Camera: Natus RetCam Envision (130° FOV); 1440 by 1080 pixels; infant wide-field fundus photograph: 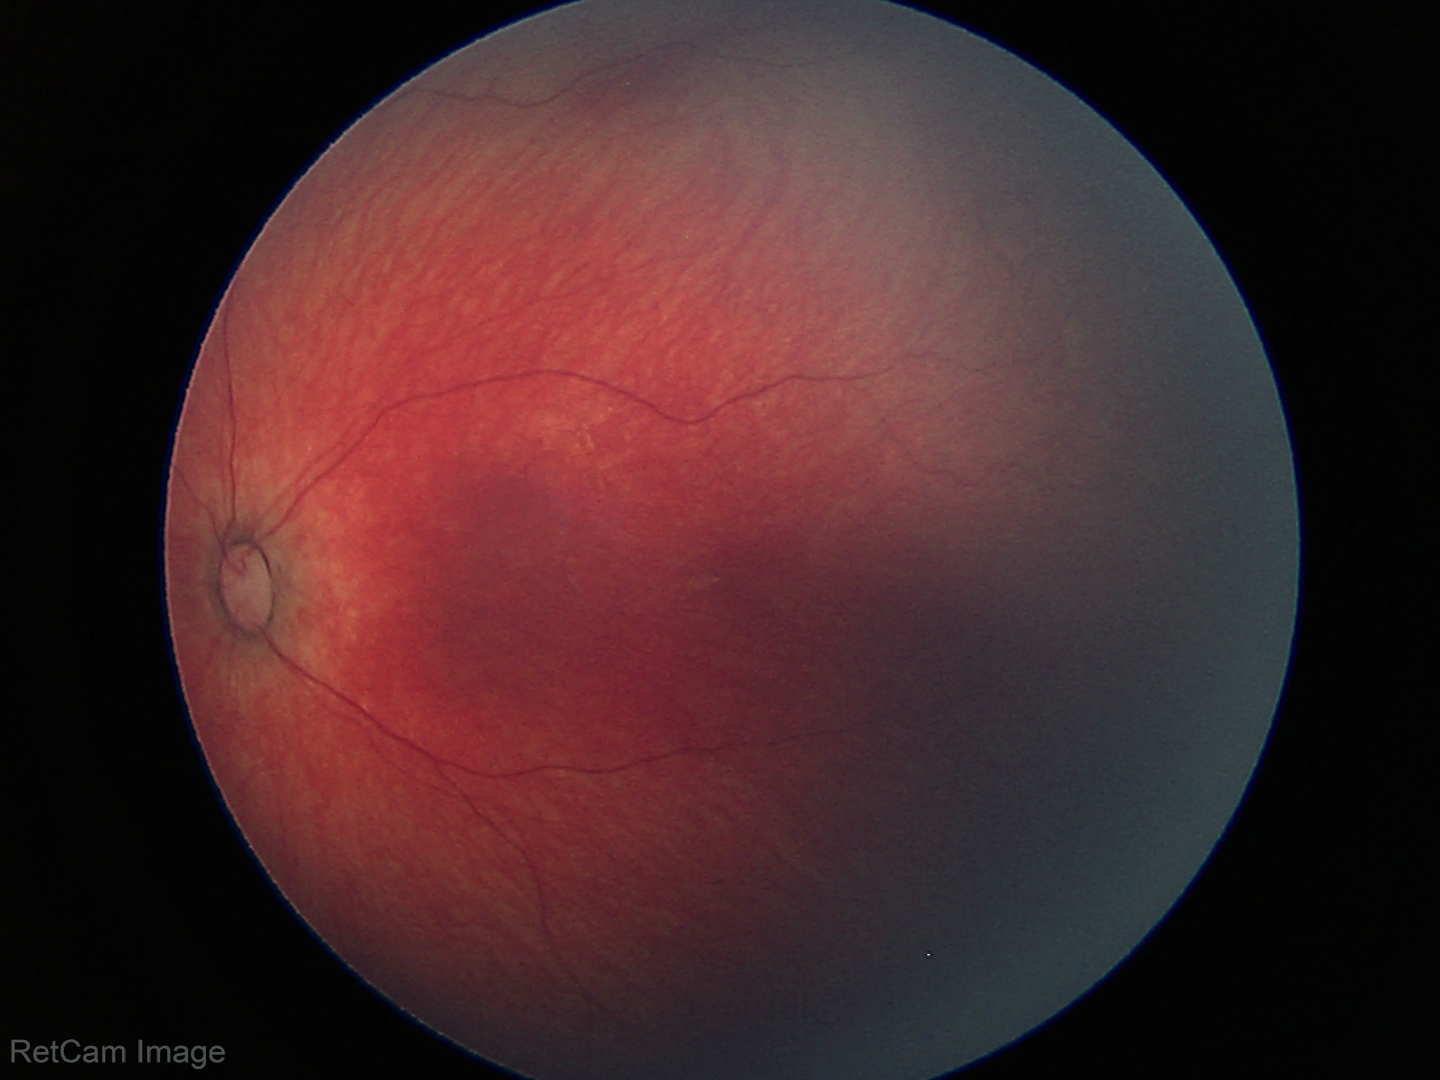
Screening diagnosis = no abnormalities.